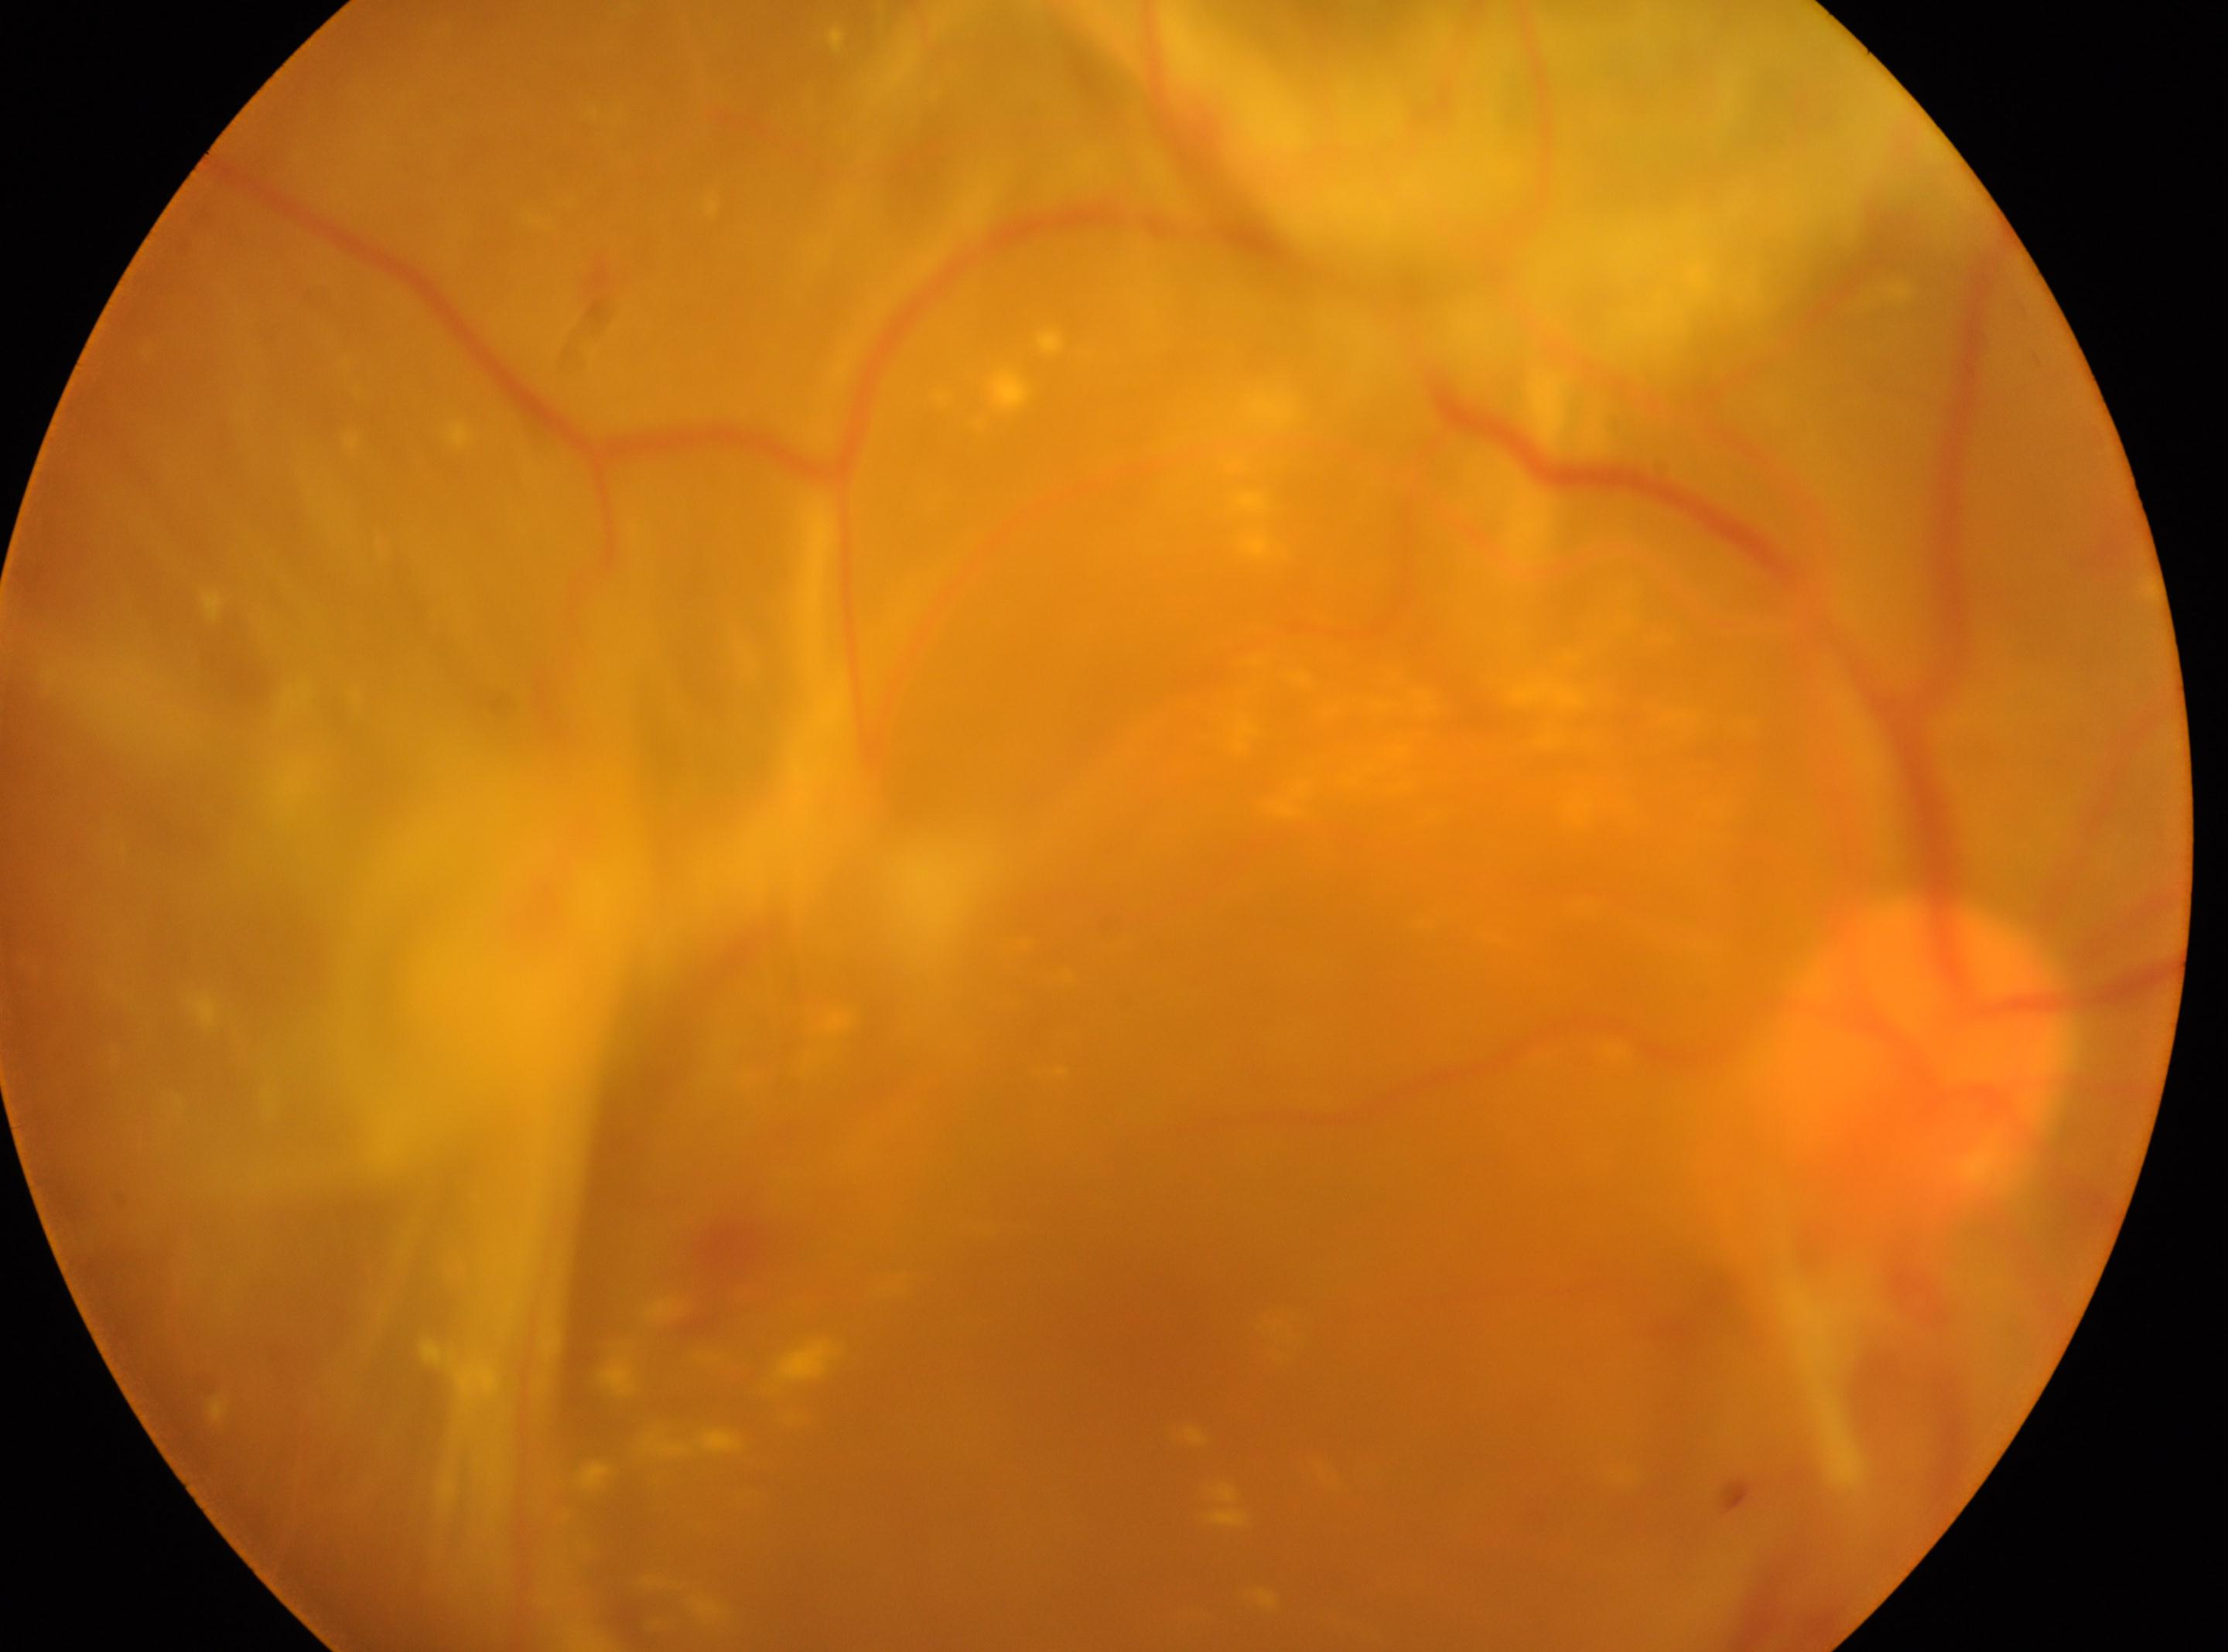   eye: right
  fovea: 1142, 1319
  dr_category: proliferative diabetic retinopathy
  dr_grade: 4
  optic_disc: 1919, 1051